2212x1659, color fundus image:
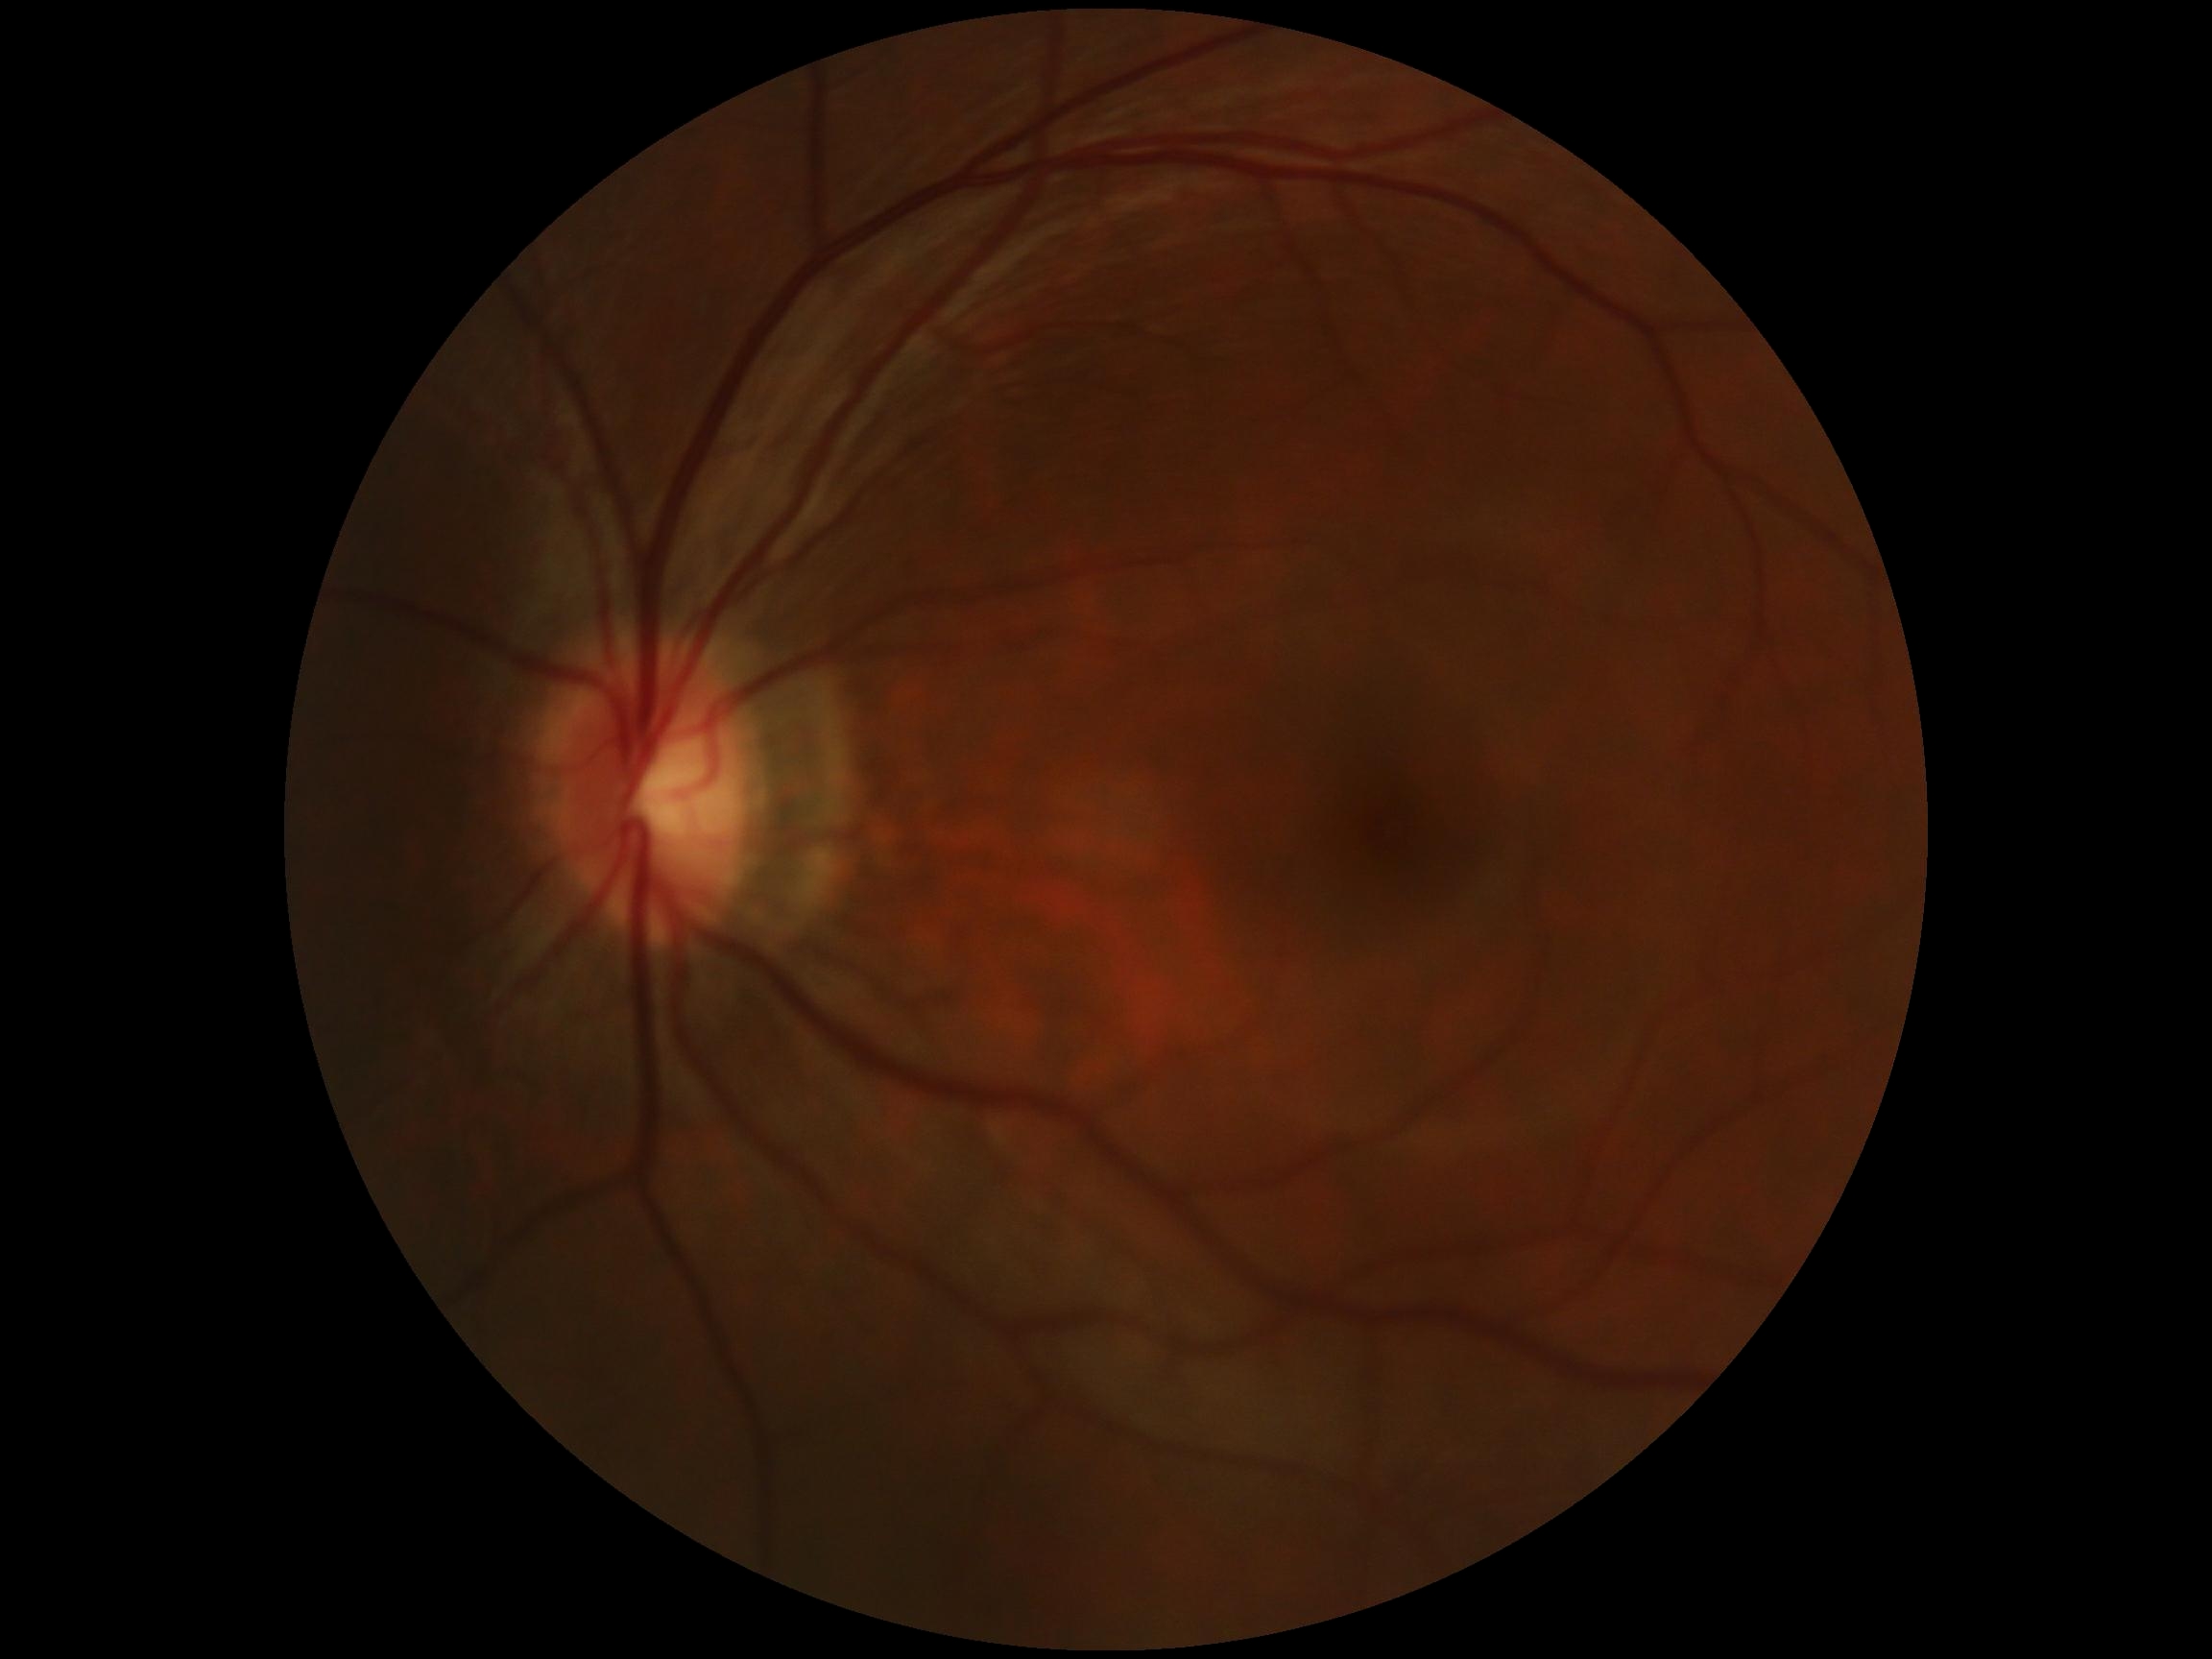 DR grade is 0 (no apparent retinopathy) — no visible signs of diabetic retinopathy.